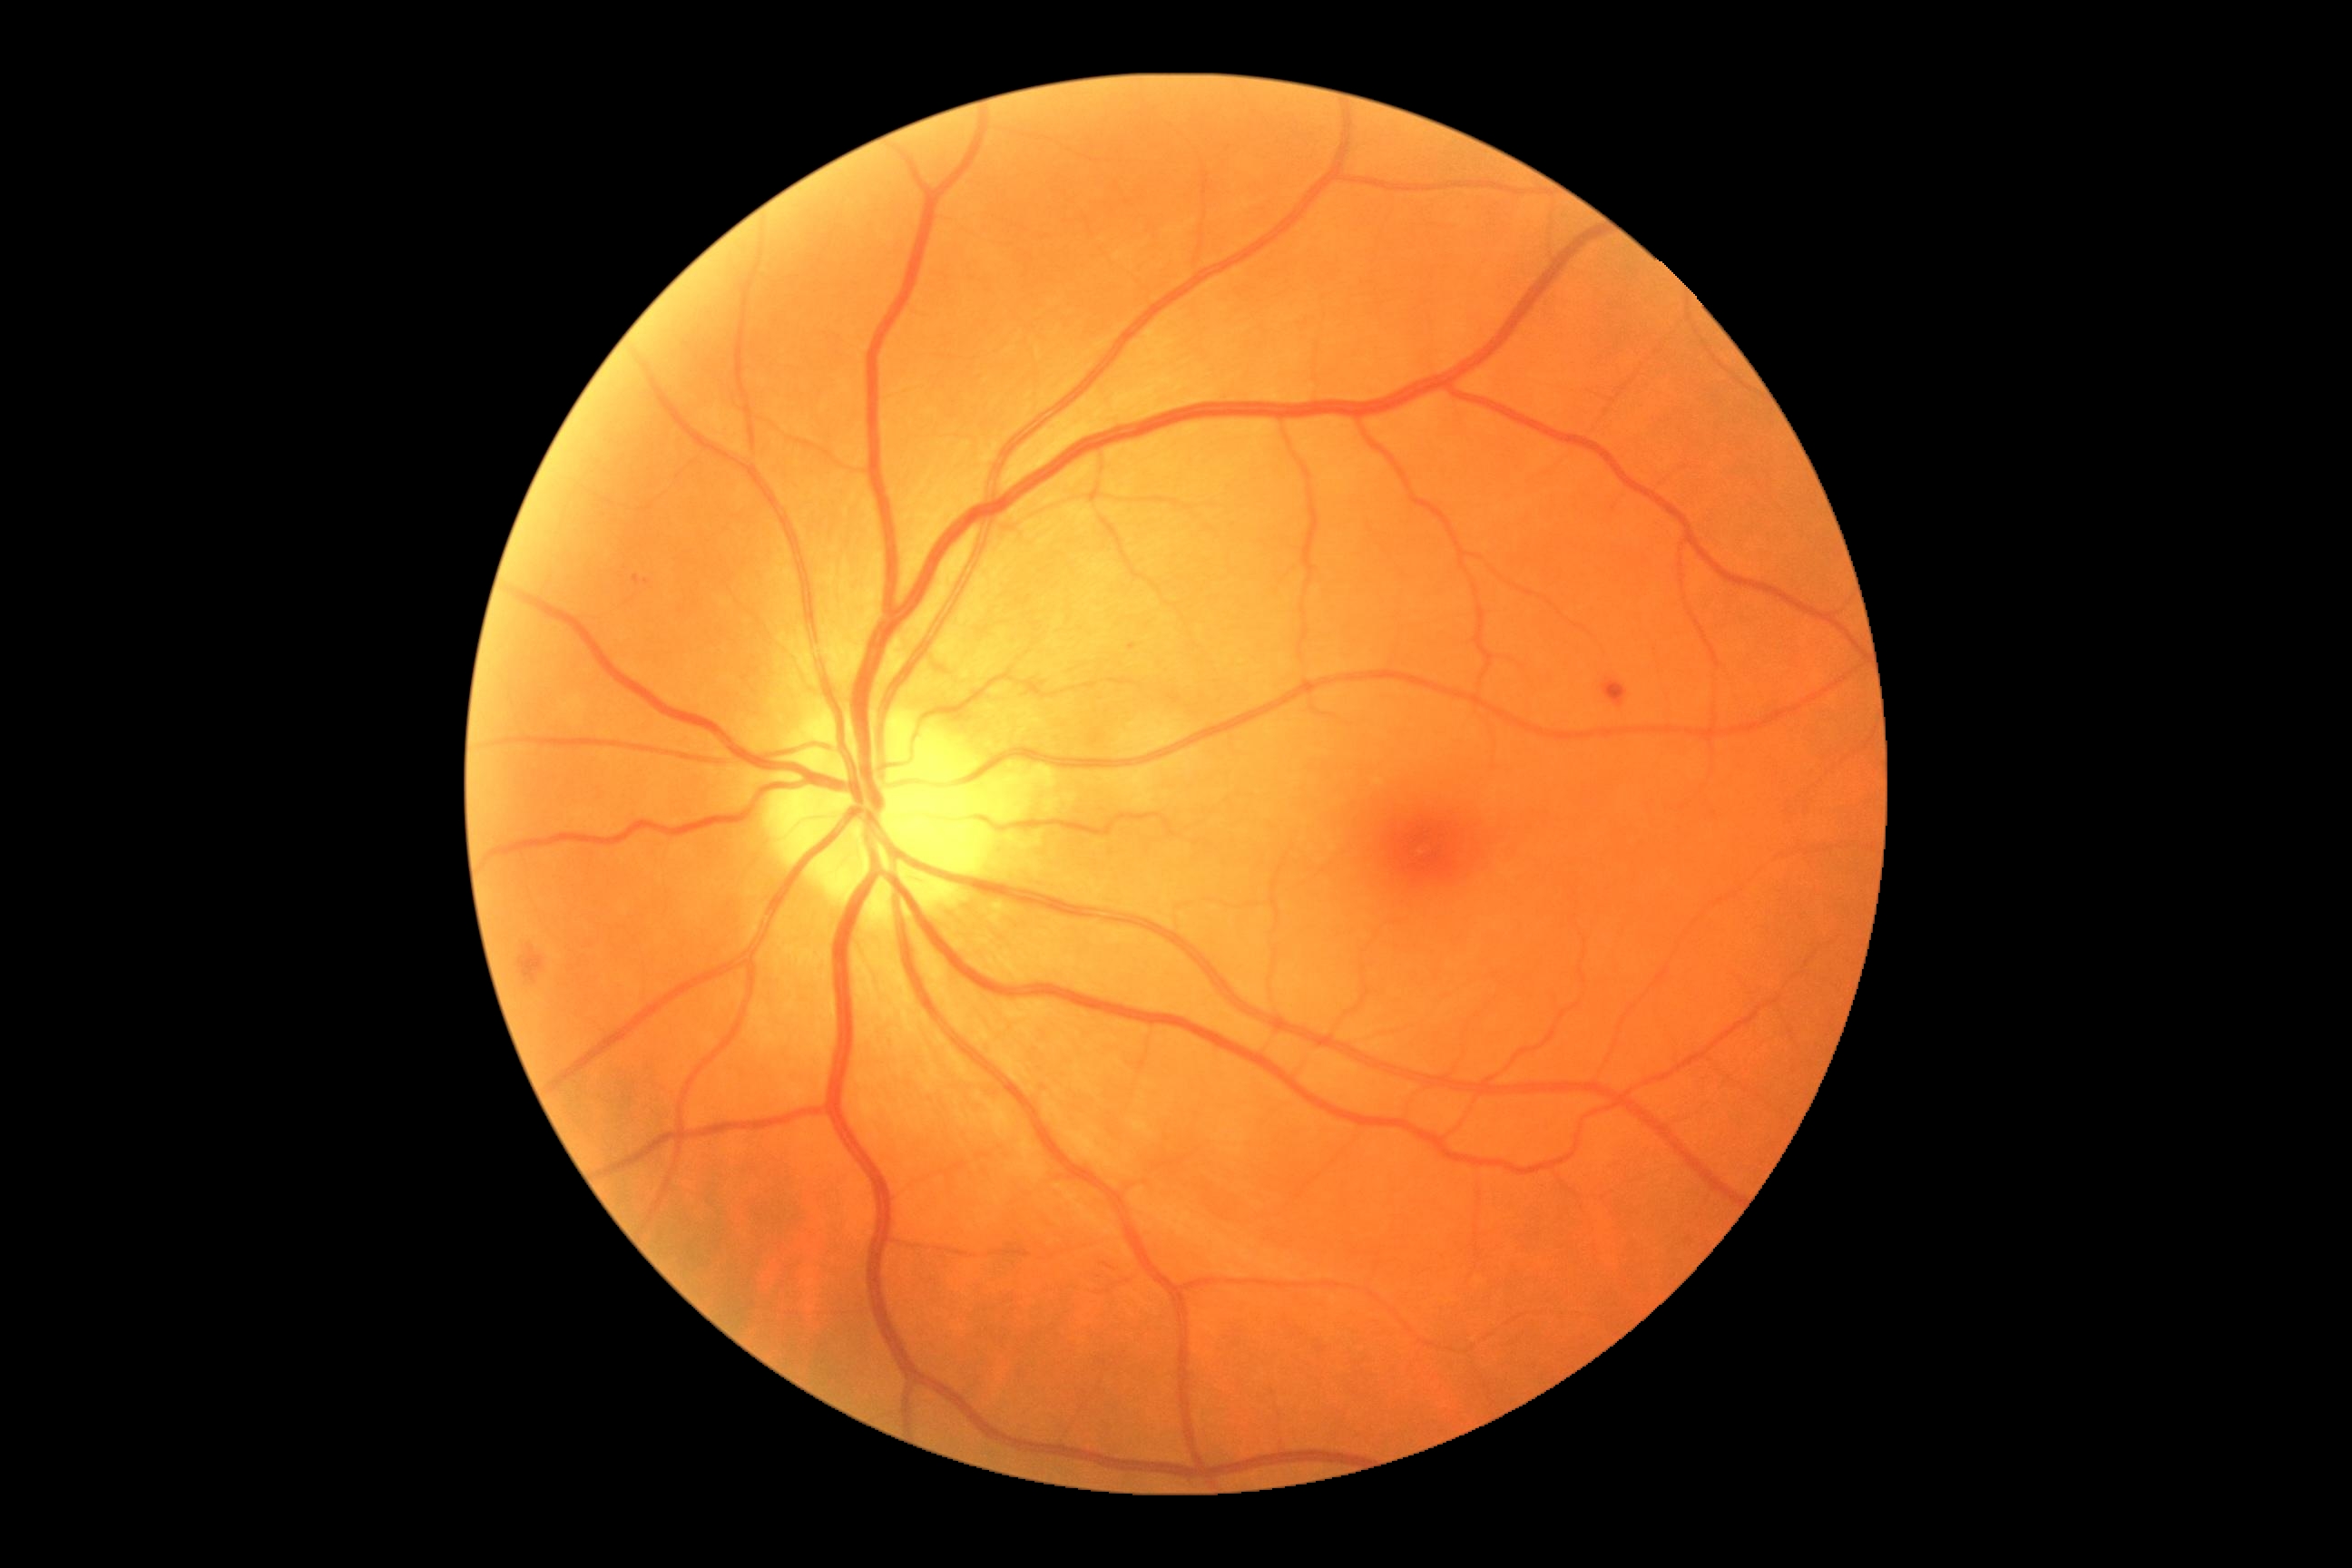

– DR severity — moderate non-proliferative diabetic retinopathy (grade 2) — more than just microaneurysms but less than severe NPDR